Acquired with a Topcon TRC-NW8: 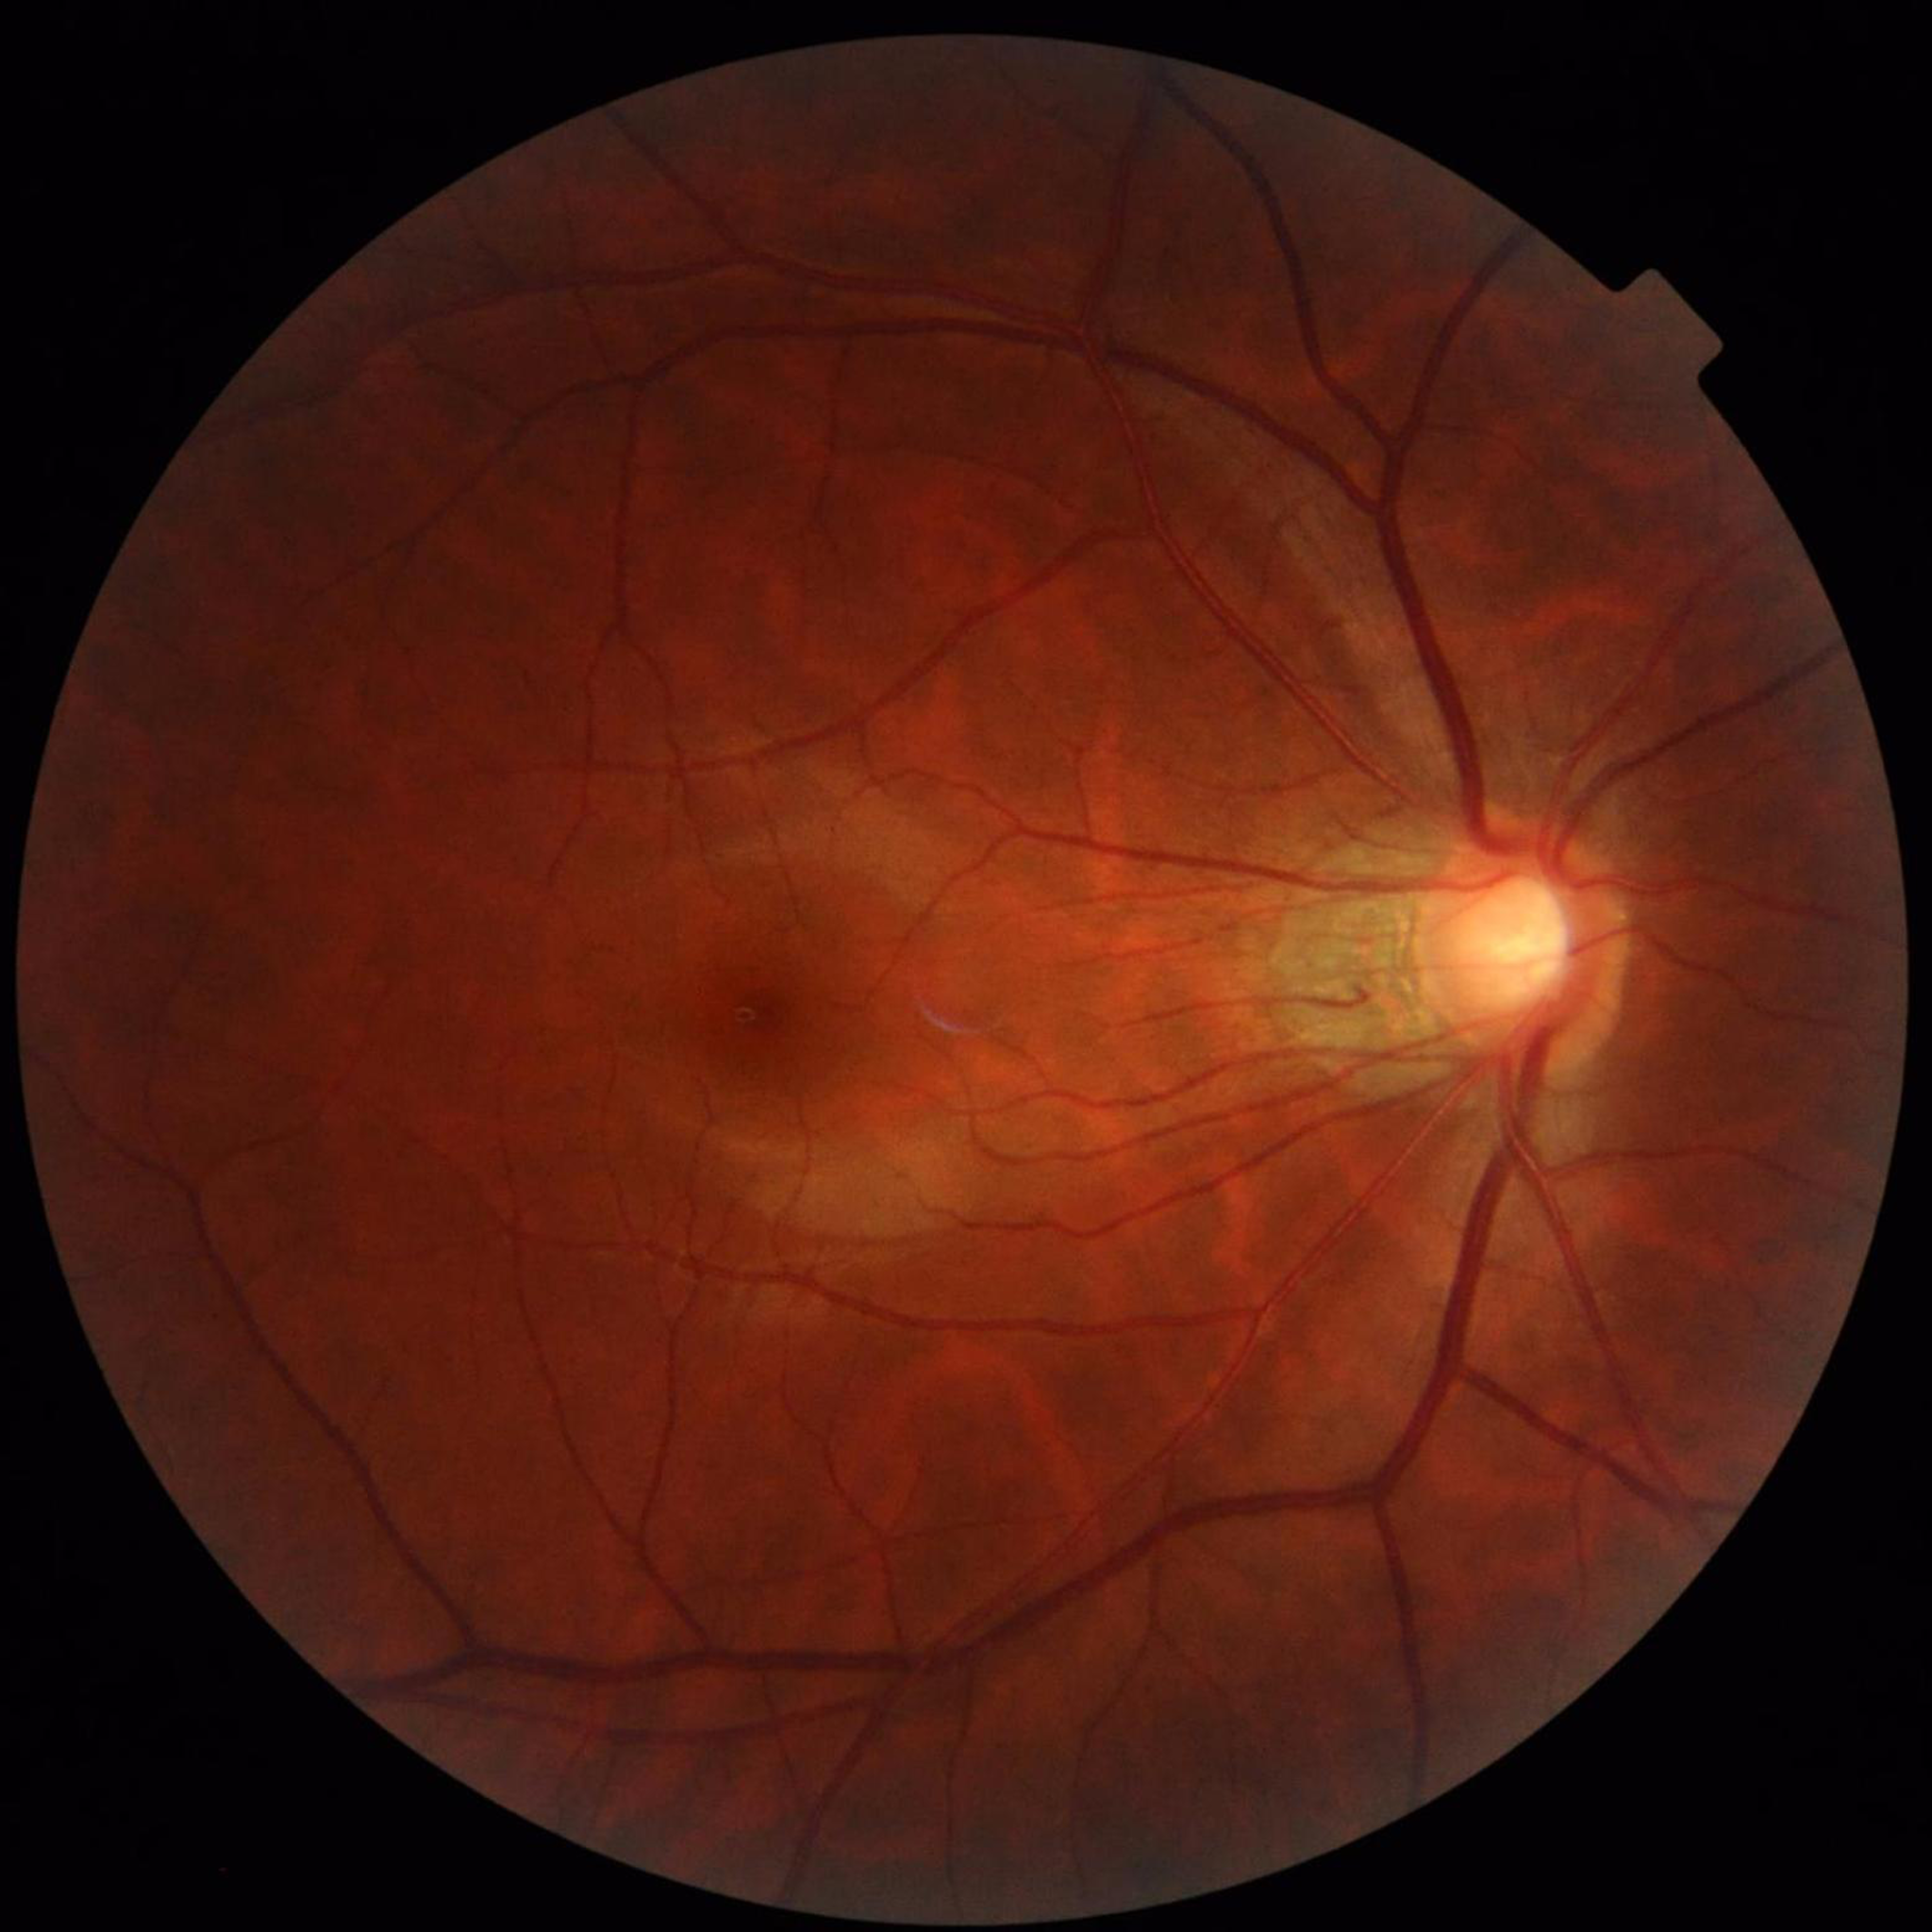
Retinal fundus photograph from a patient with glaucoma.
Quality: no blur, contrast adequate, illumination and color satisfactory.